Camera: Bosch handheld fundus camera:
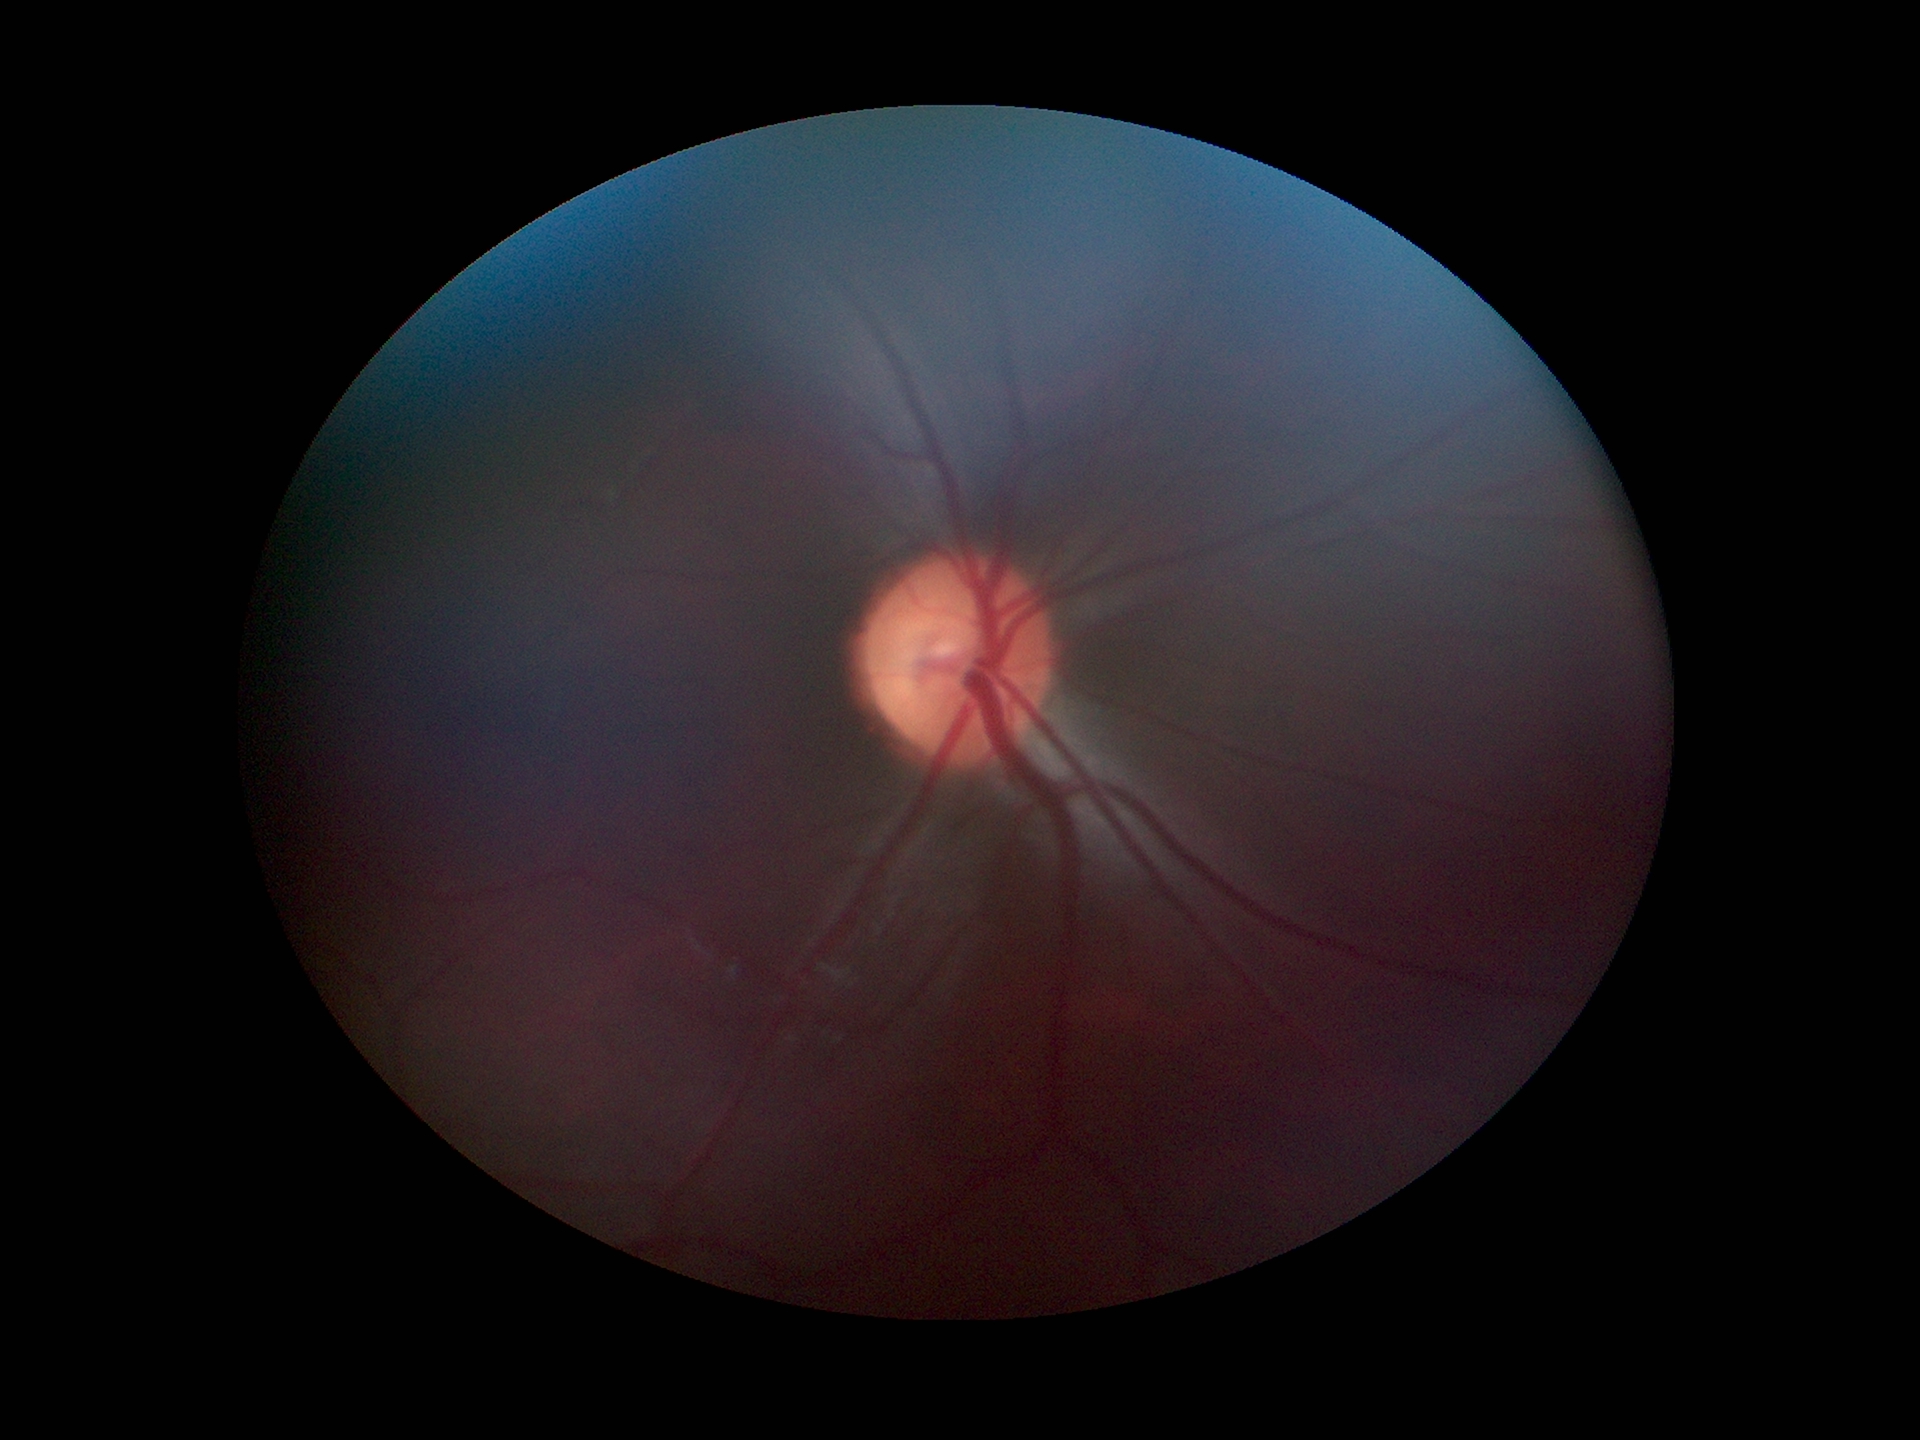

Horizontal cup-disc ratio is 0.55. Vertical CDR: 0.51. No signs of glaucoma.